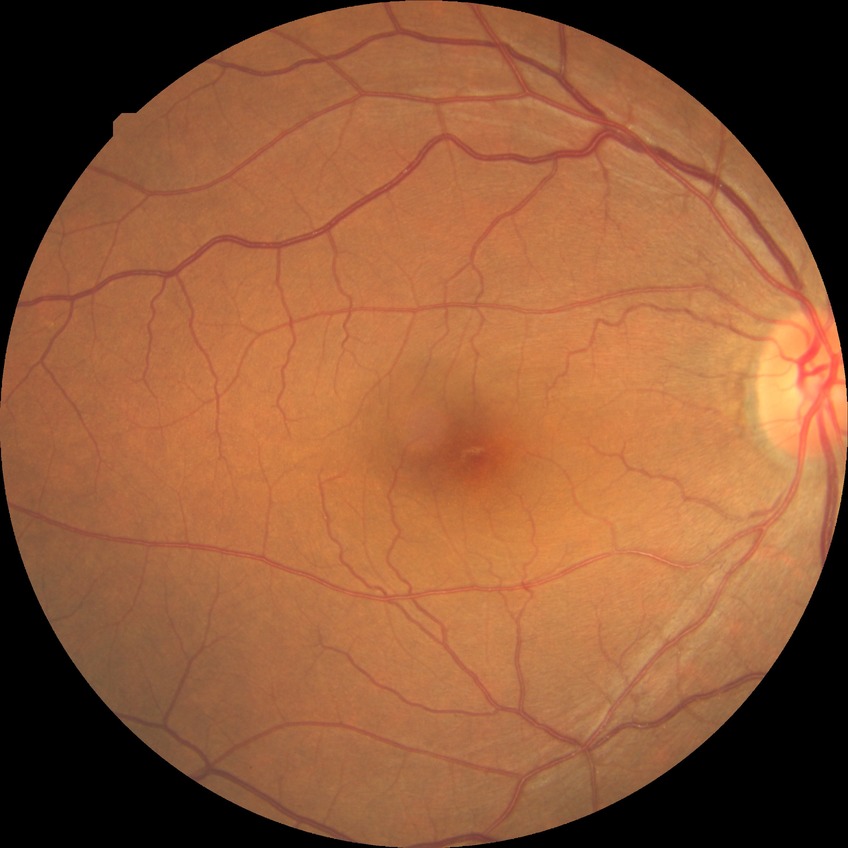

diabetic retinopathy grade: no diabetic retinopathy.